Fundus photo. Image size 2352x1568. 45° FOV — 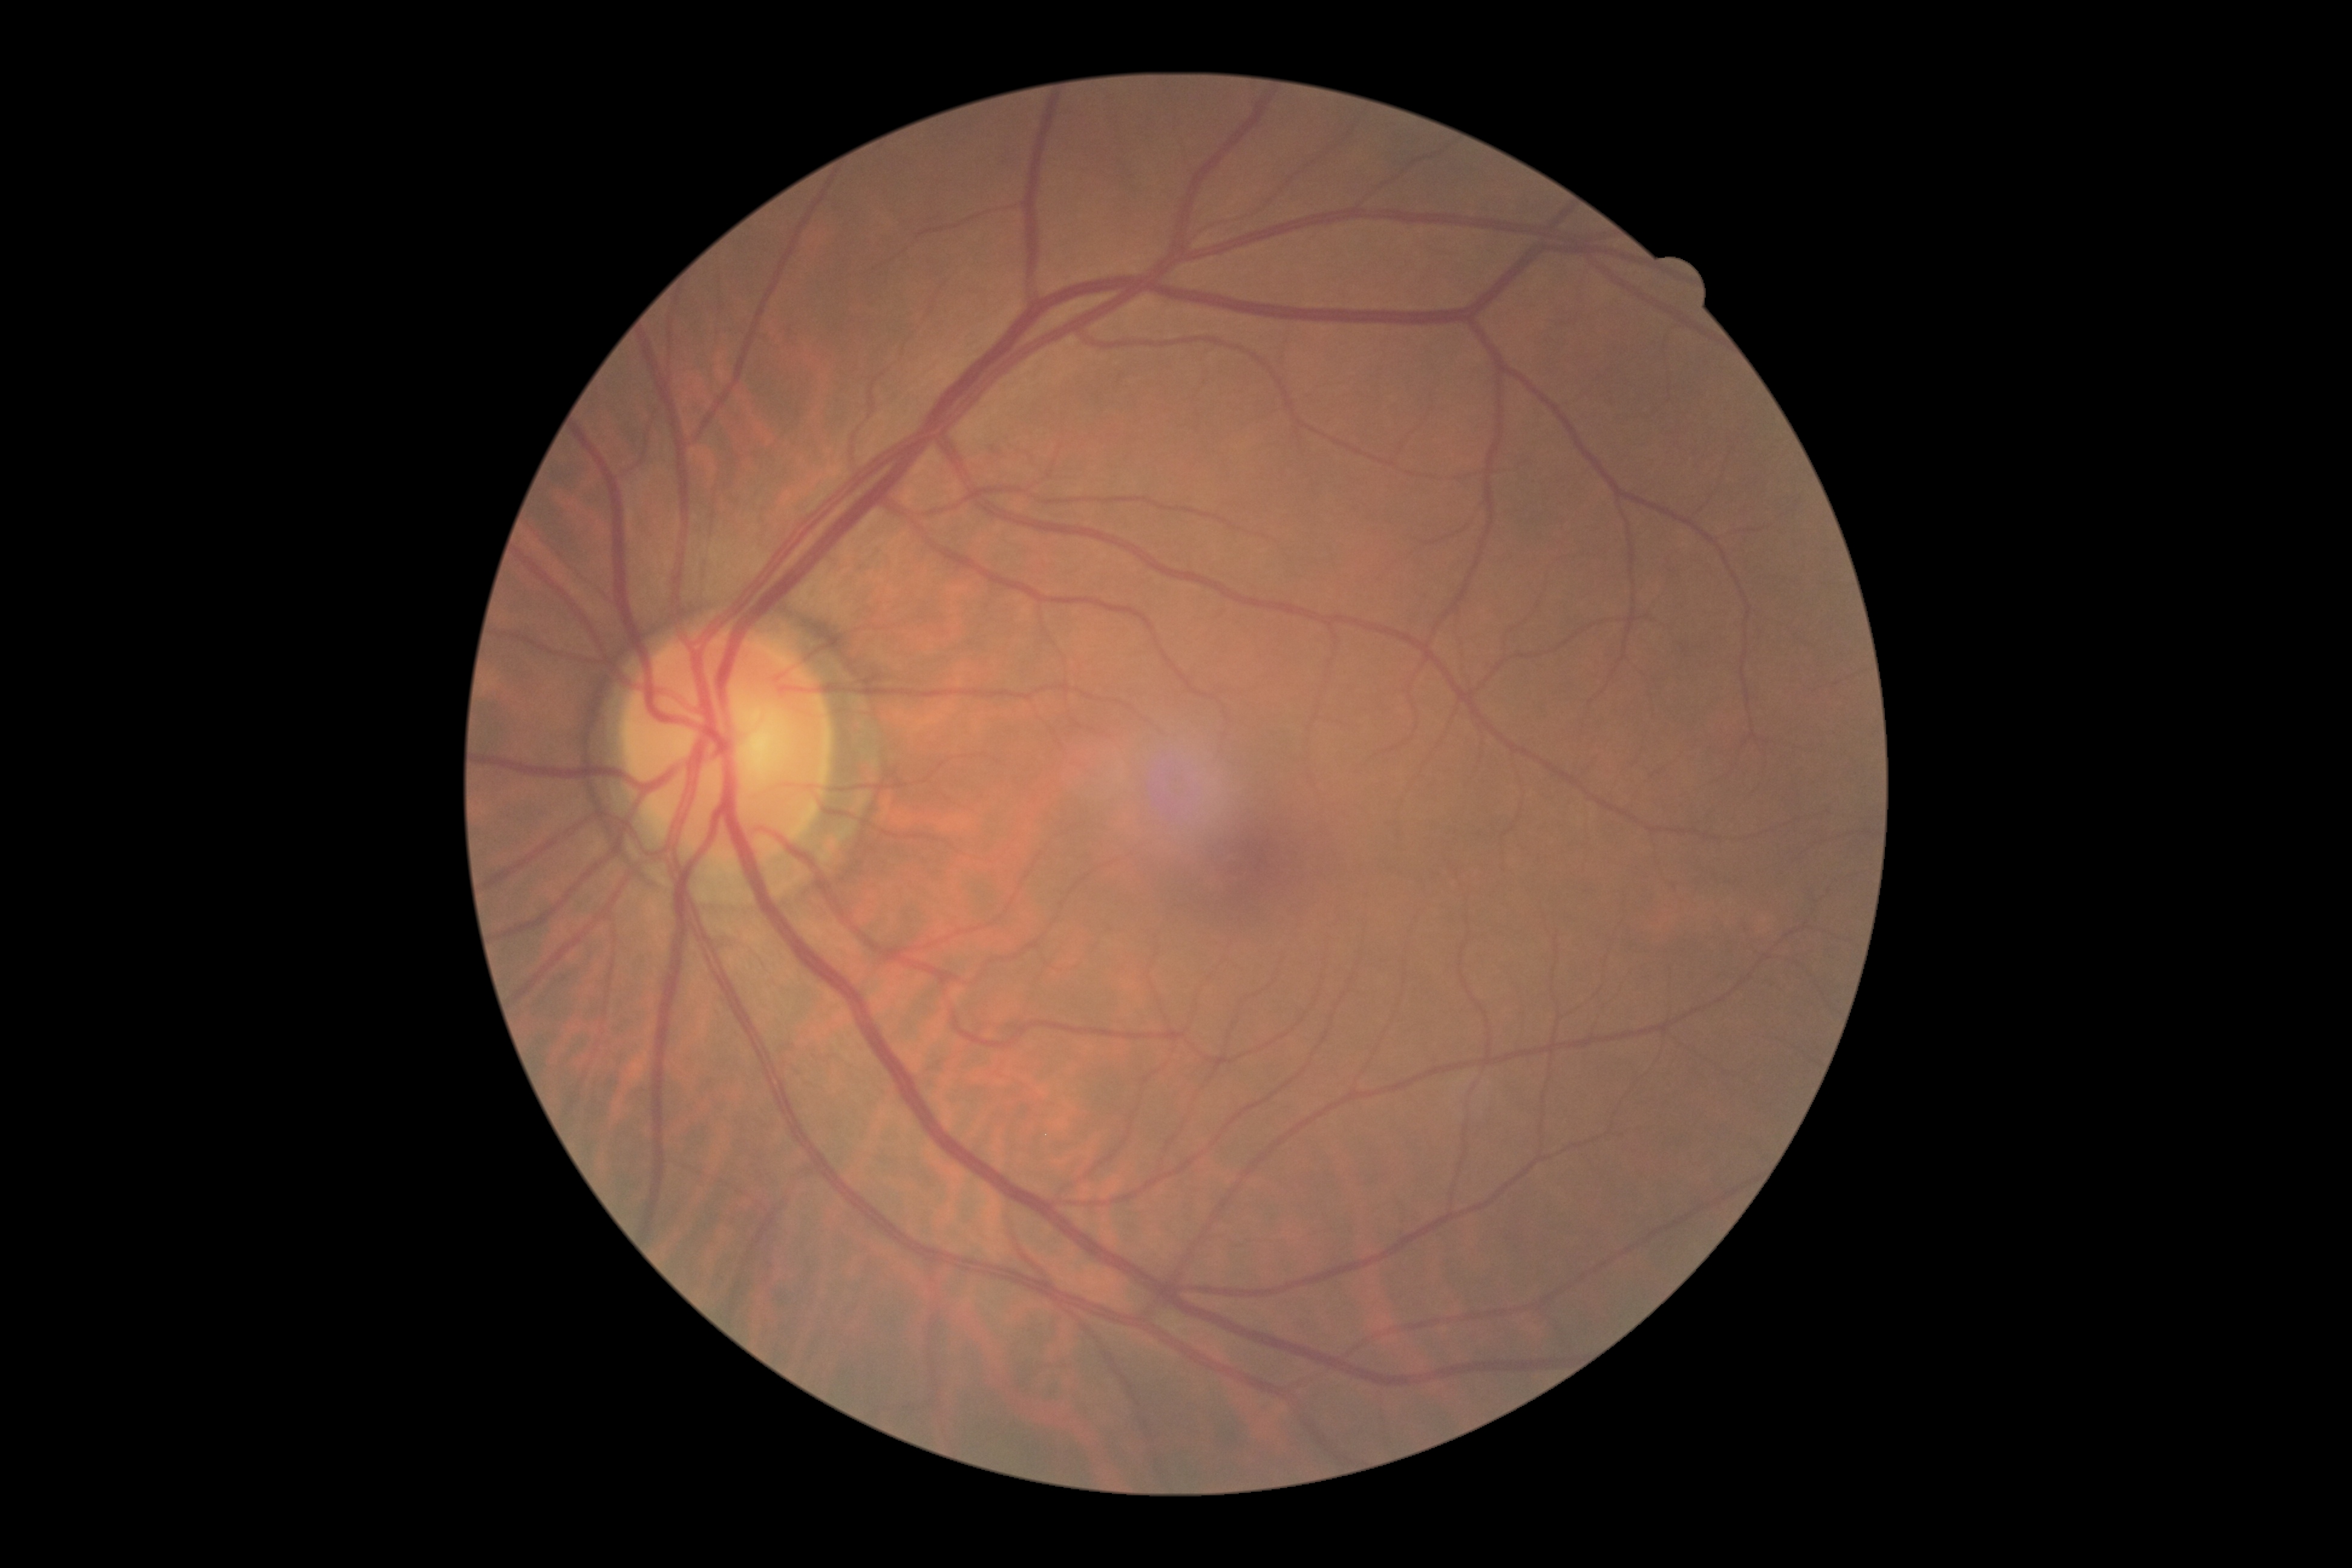

DR stage: 0.